1440x1080. Camera: Natus RetCam Envision (130° FOV). Wide-field fundus photograph of an infant:
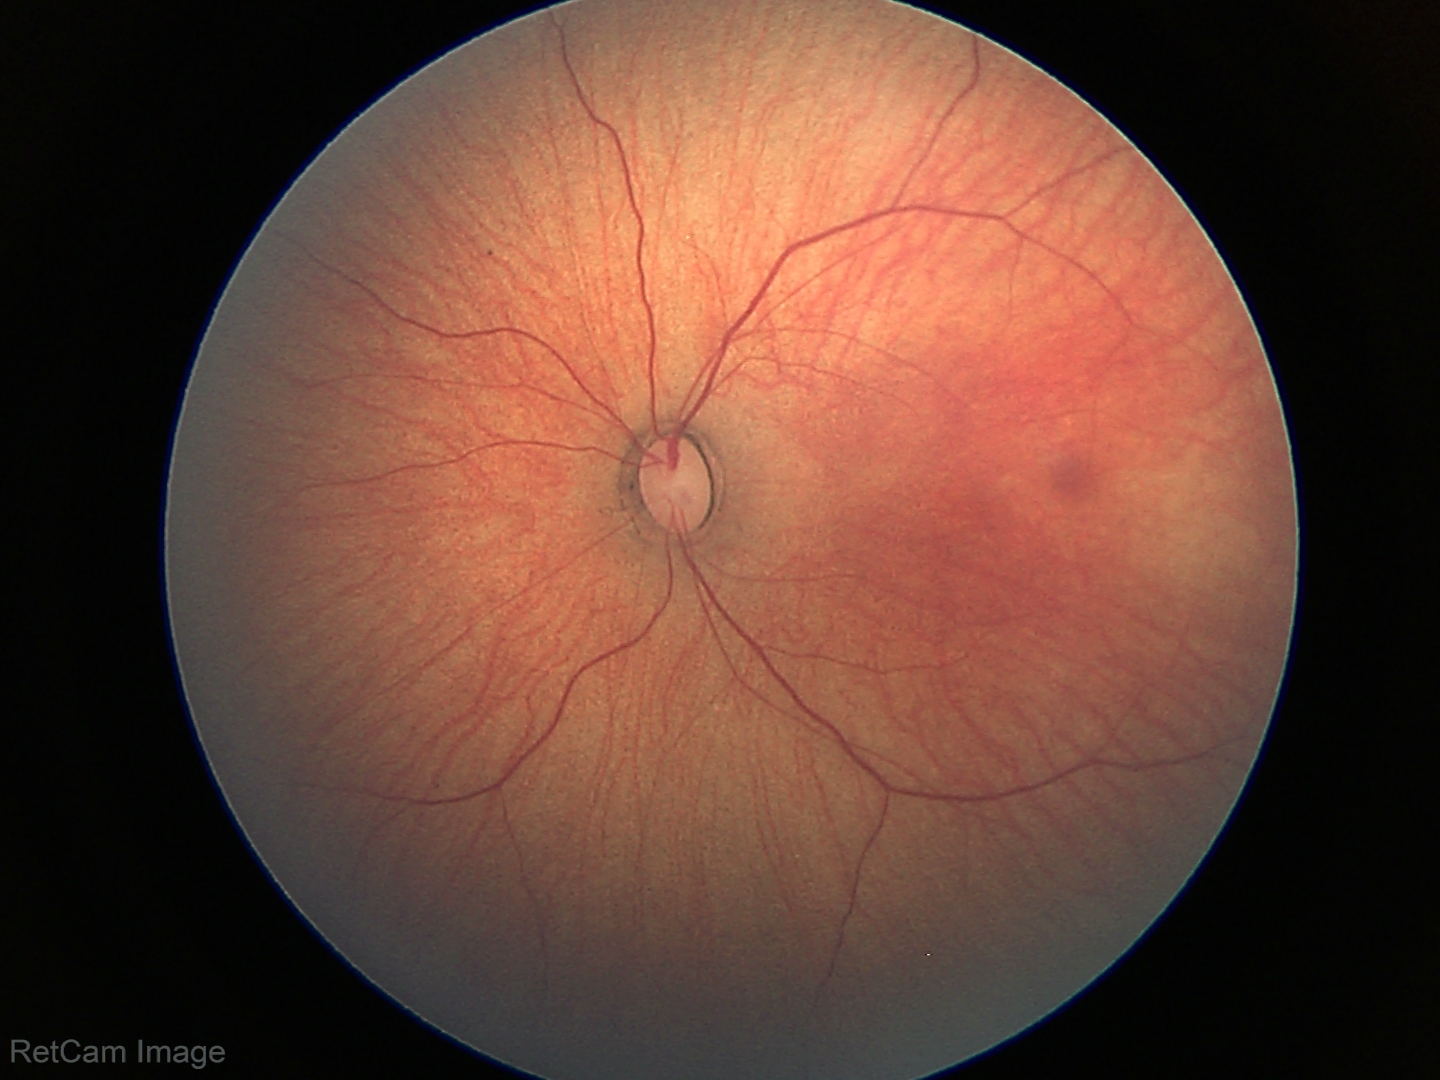
Physiological retinal appearance for postconceptual age.